45 degree fundus photograph
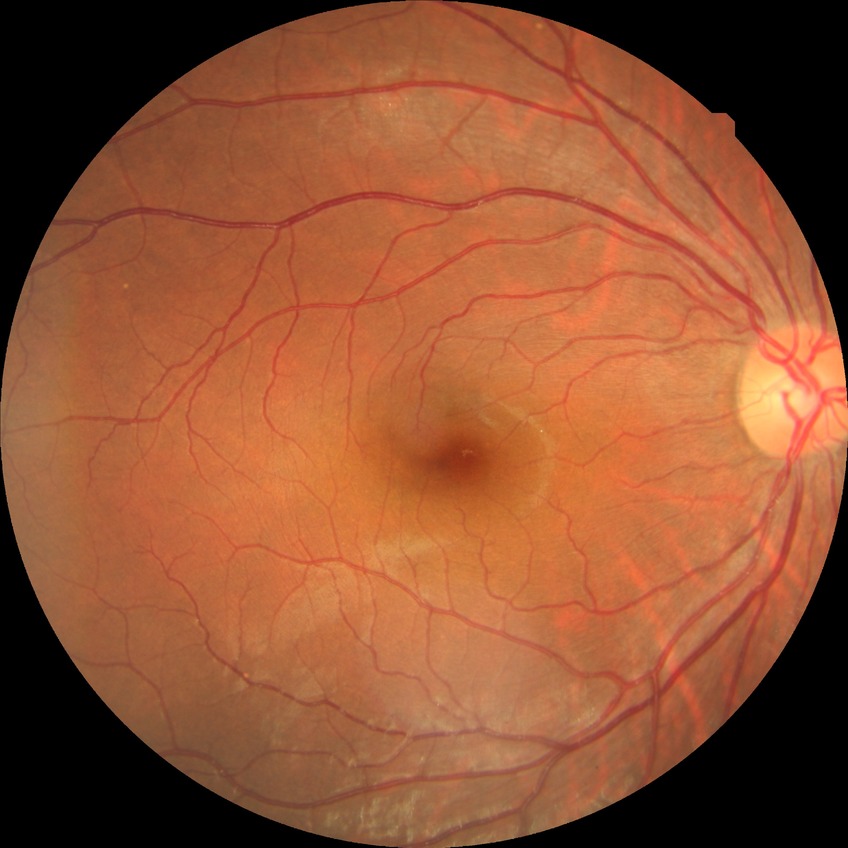

diabetic retinopathy (DR) = no diabetic retinopathy (NDR)